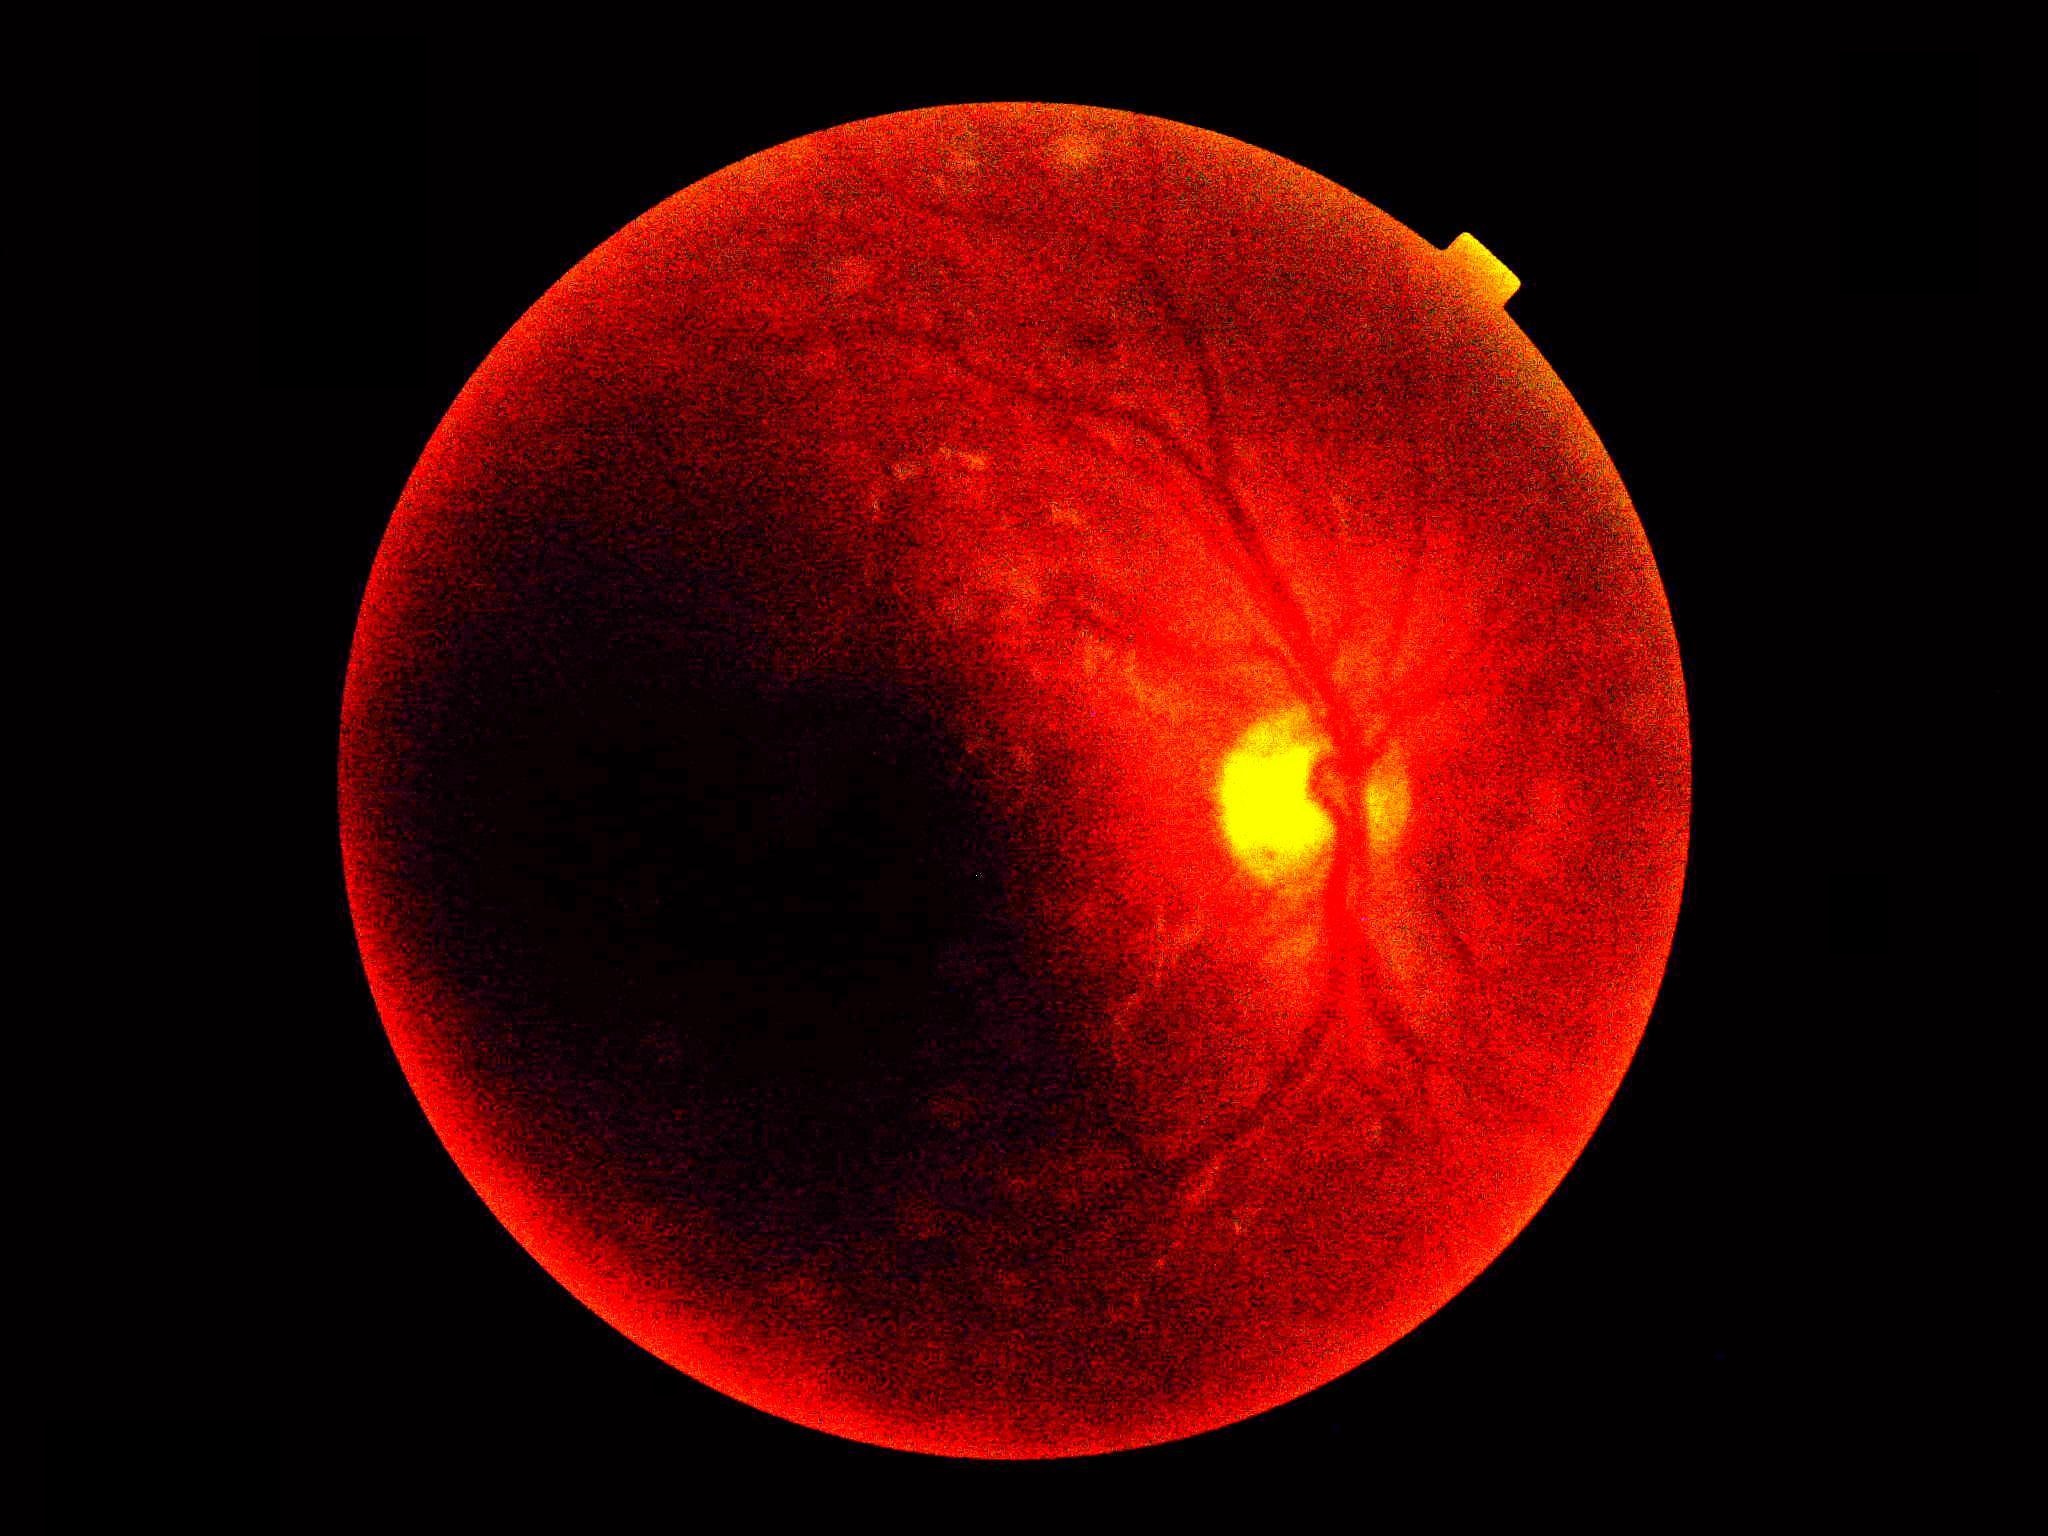
image quality = insufficient for DR assessment
DR grade = ungradable